45° FOV: 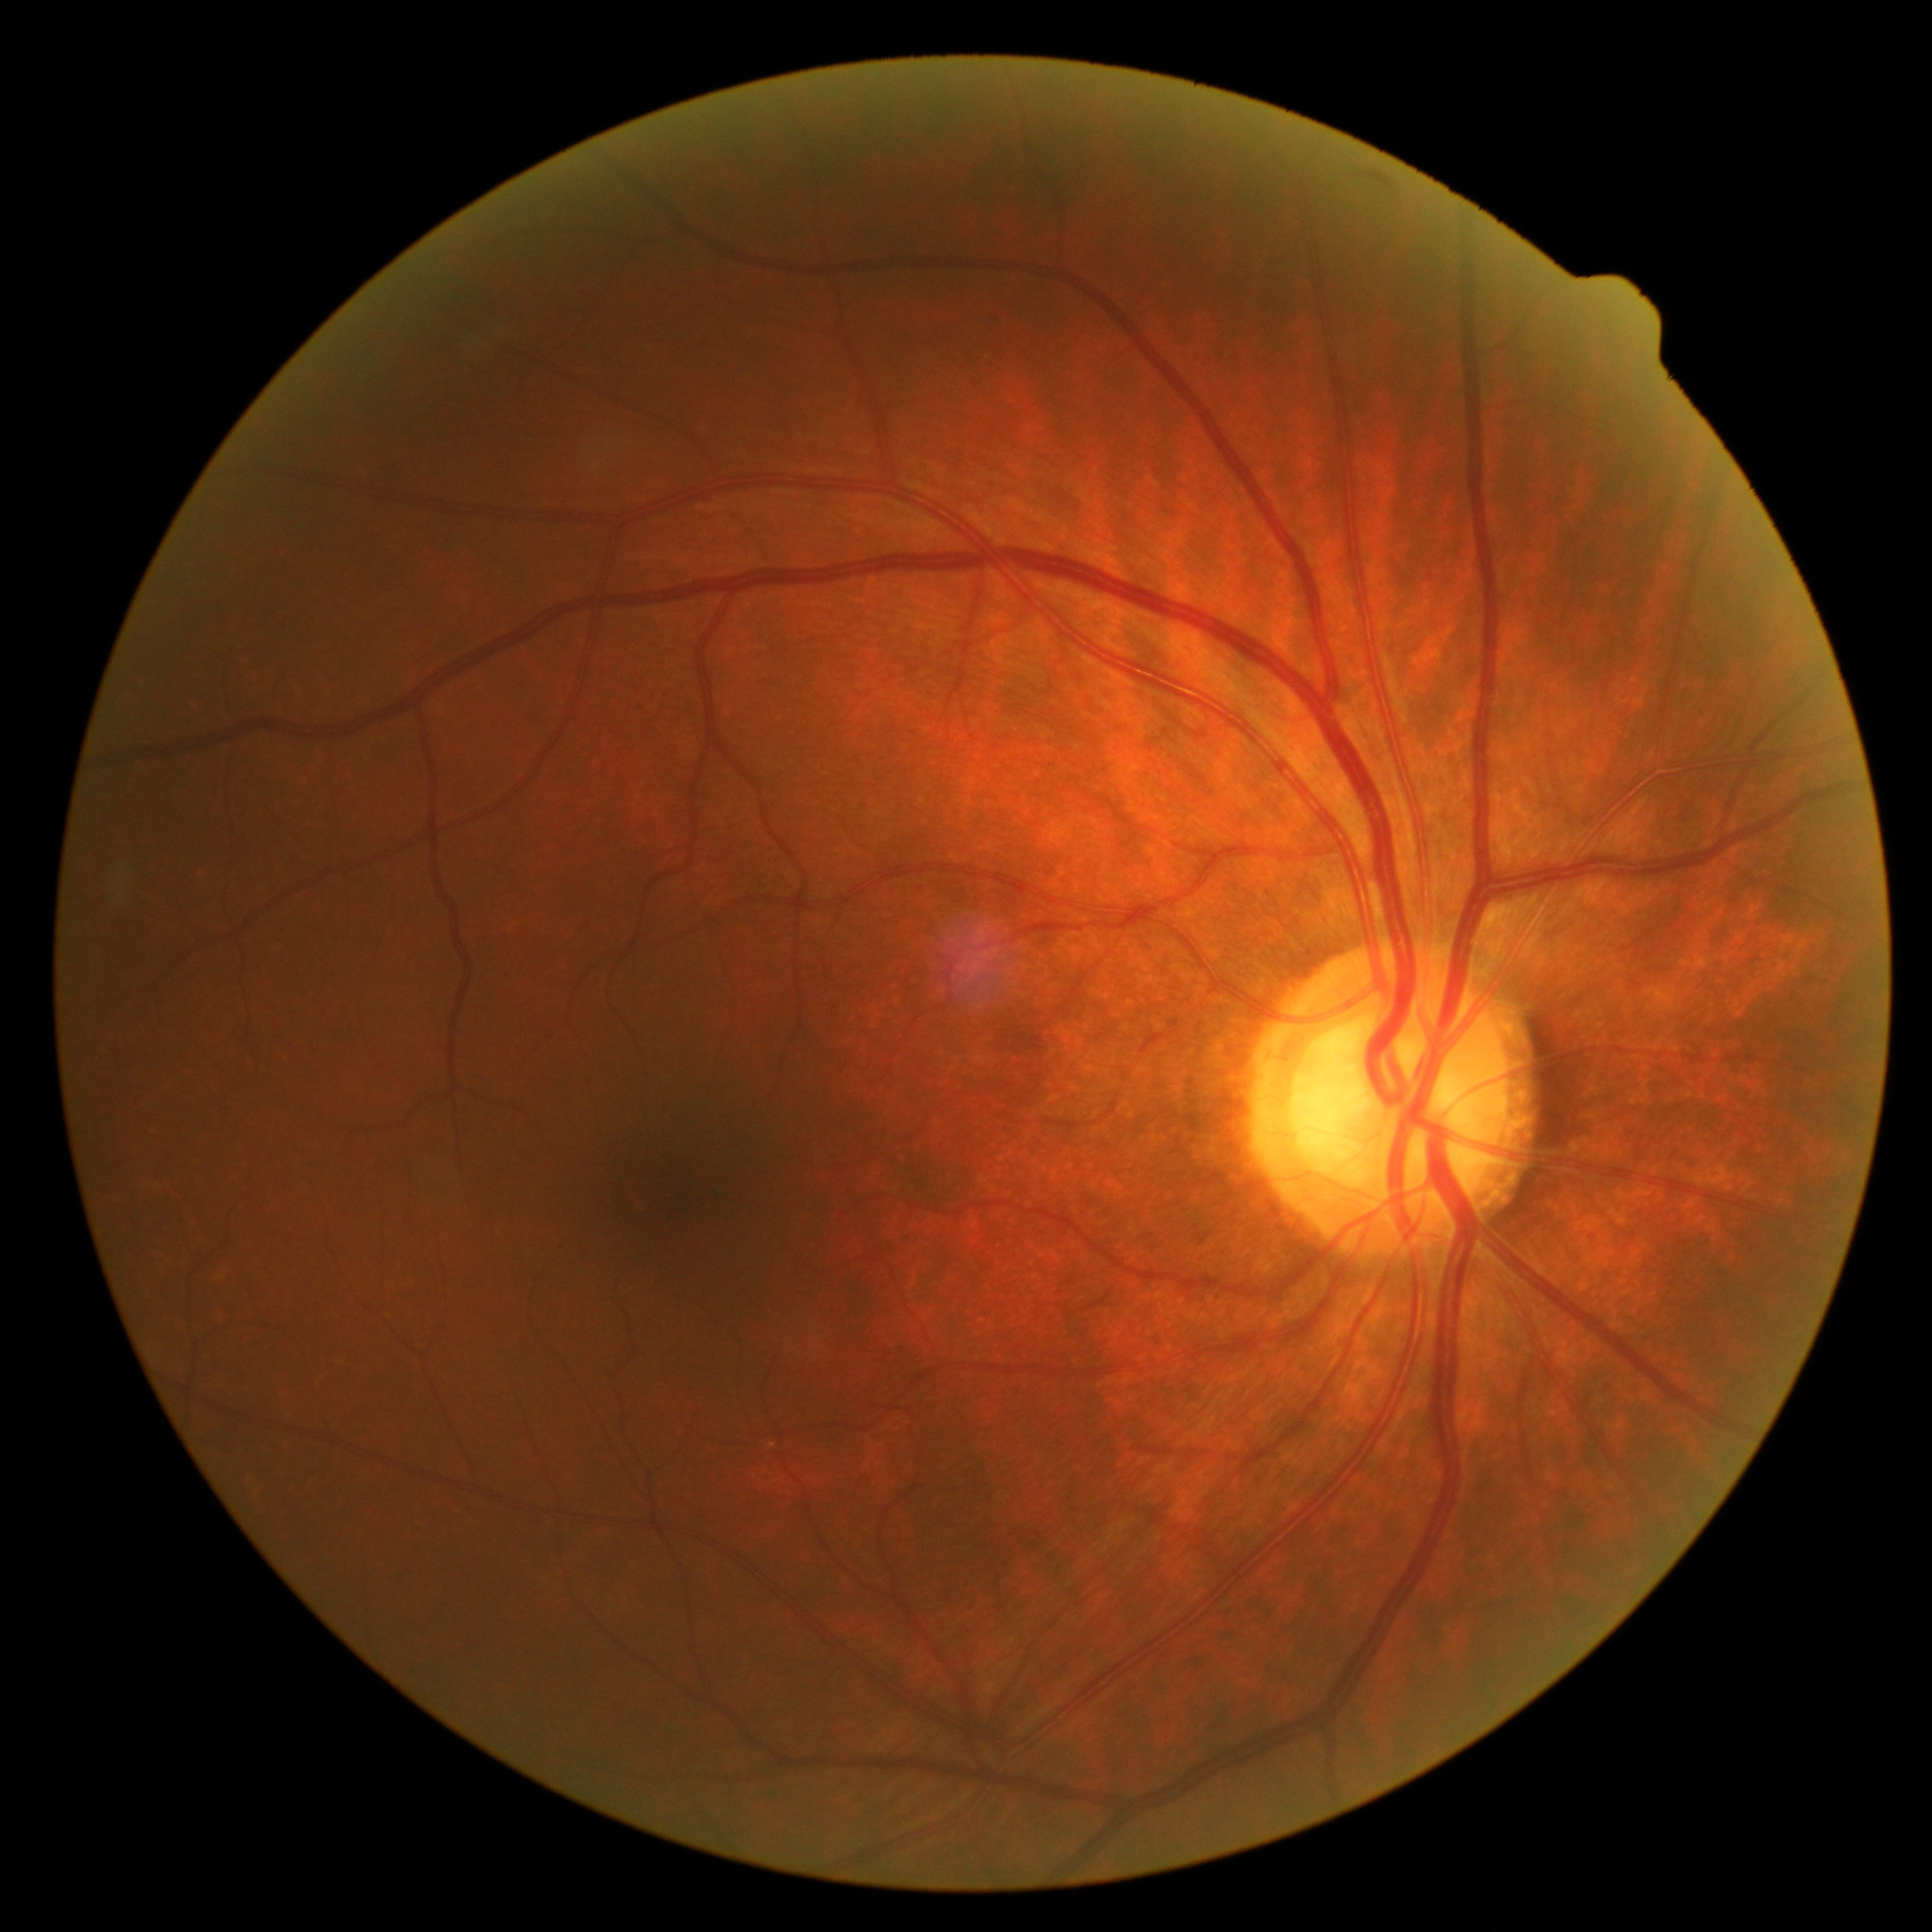
diabetic retinopathy severity = grade 0 (no apparent retinopathy) | DR impression = no signs of DR.